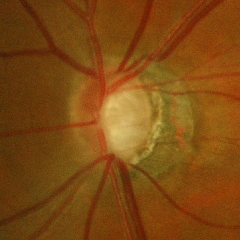

Findings consistent with glaucoma. Glaucoma status: early glaucomatous changes.